2352x1568px, color fundus photograph.
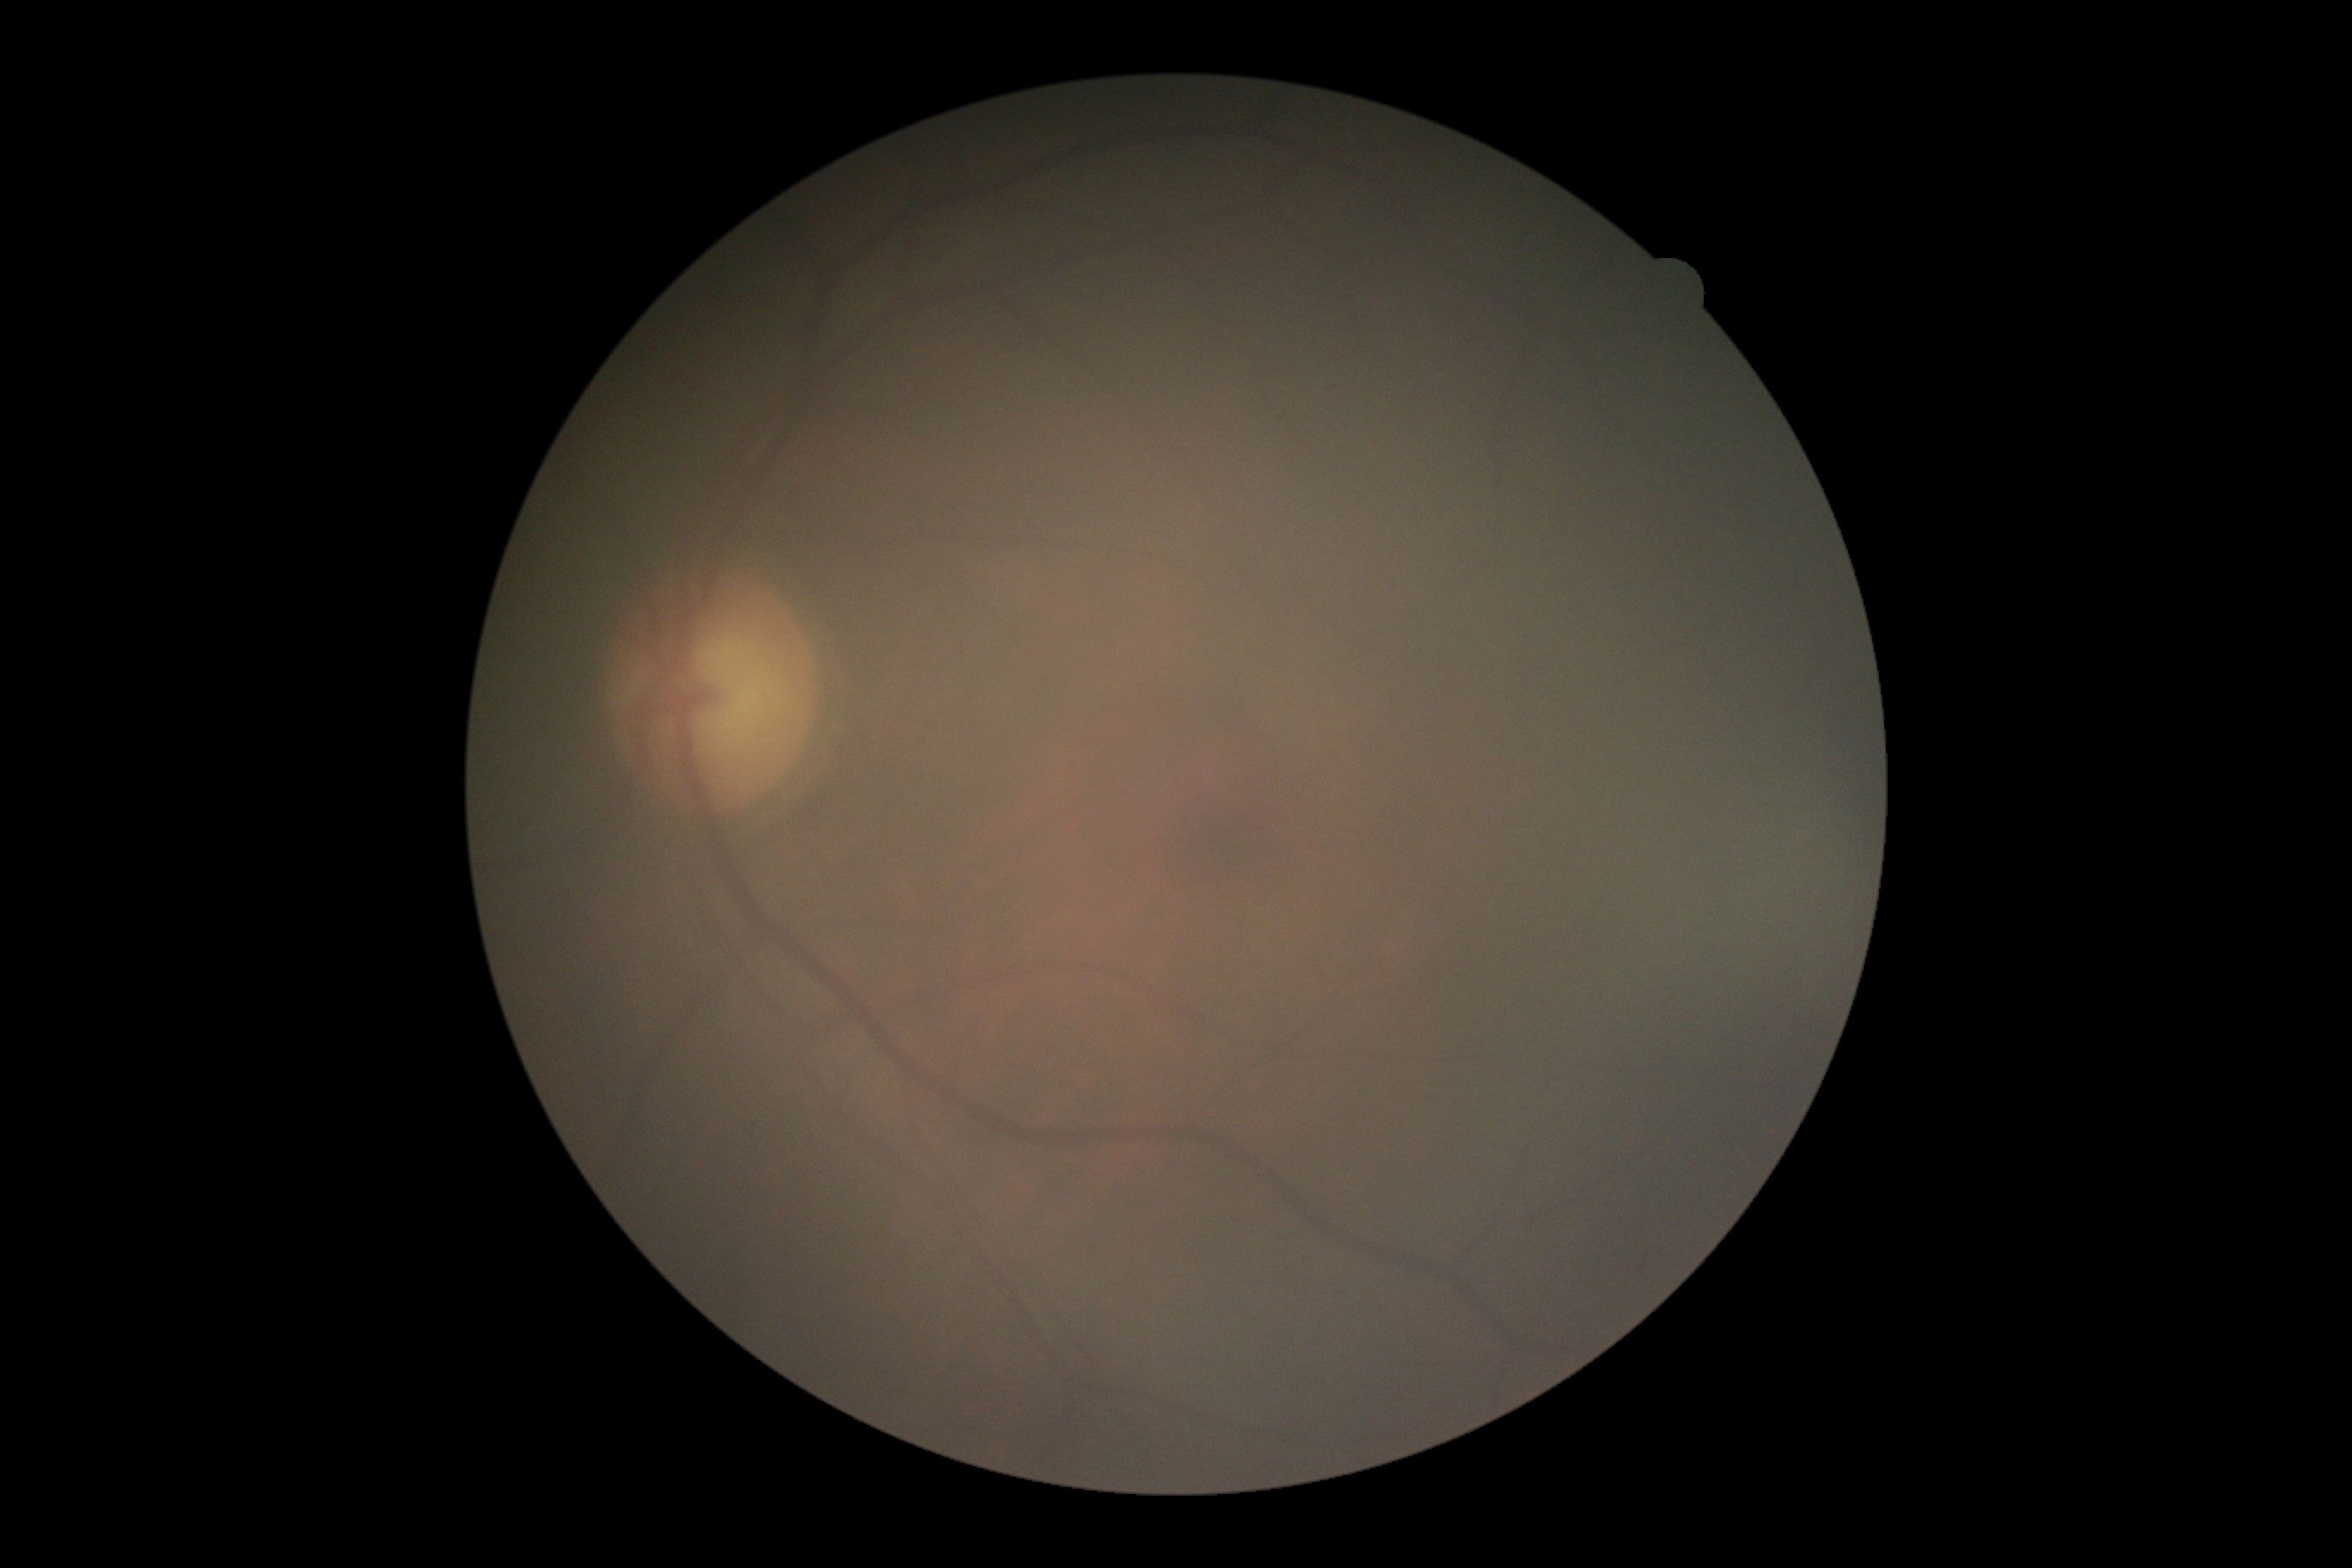 Diabetic retinopathy (DR) is grade 0 (no apparent retinopathy).